Image size 848x848; FOV: 45 degrees — 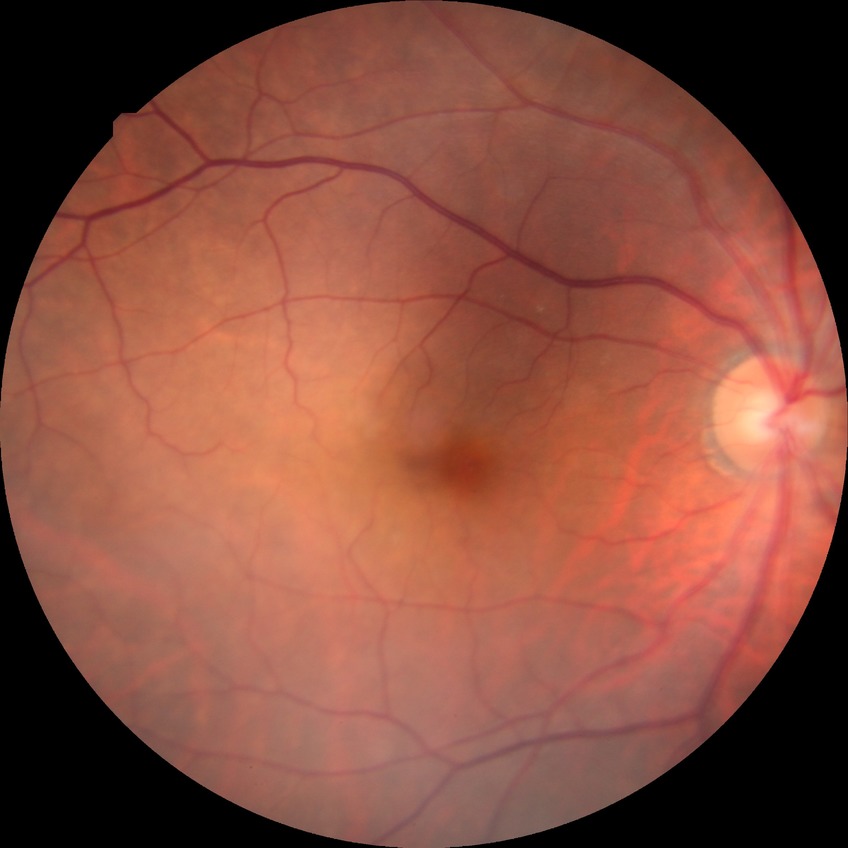

diabetic retinopathy (DR)=SDR (simple diabetic retinopathy).